Color fundus photograph:
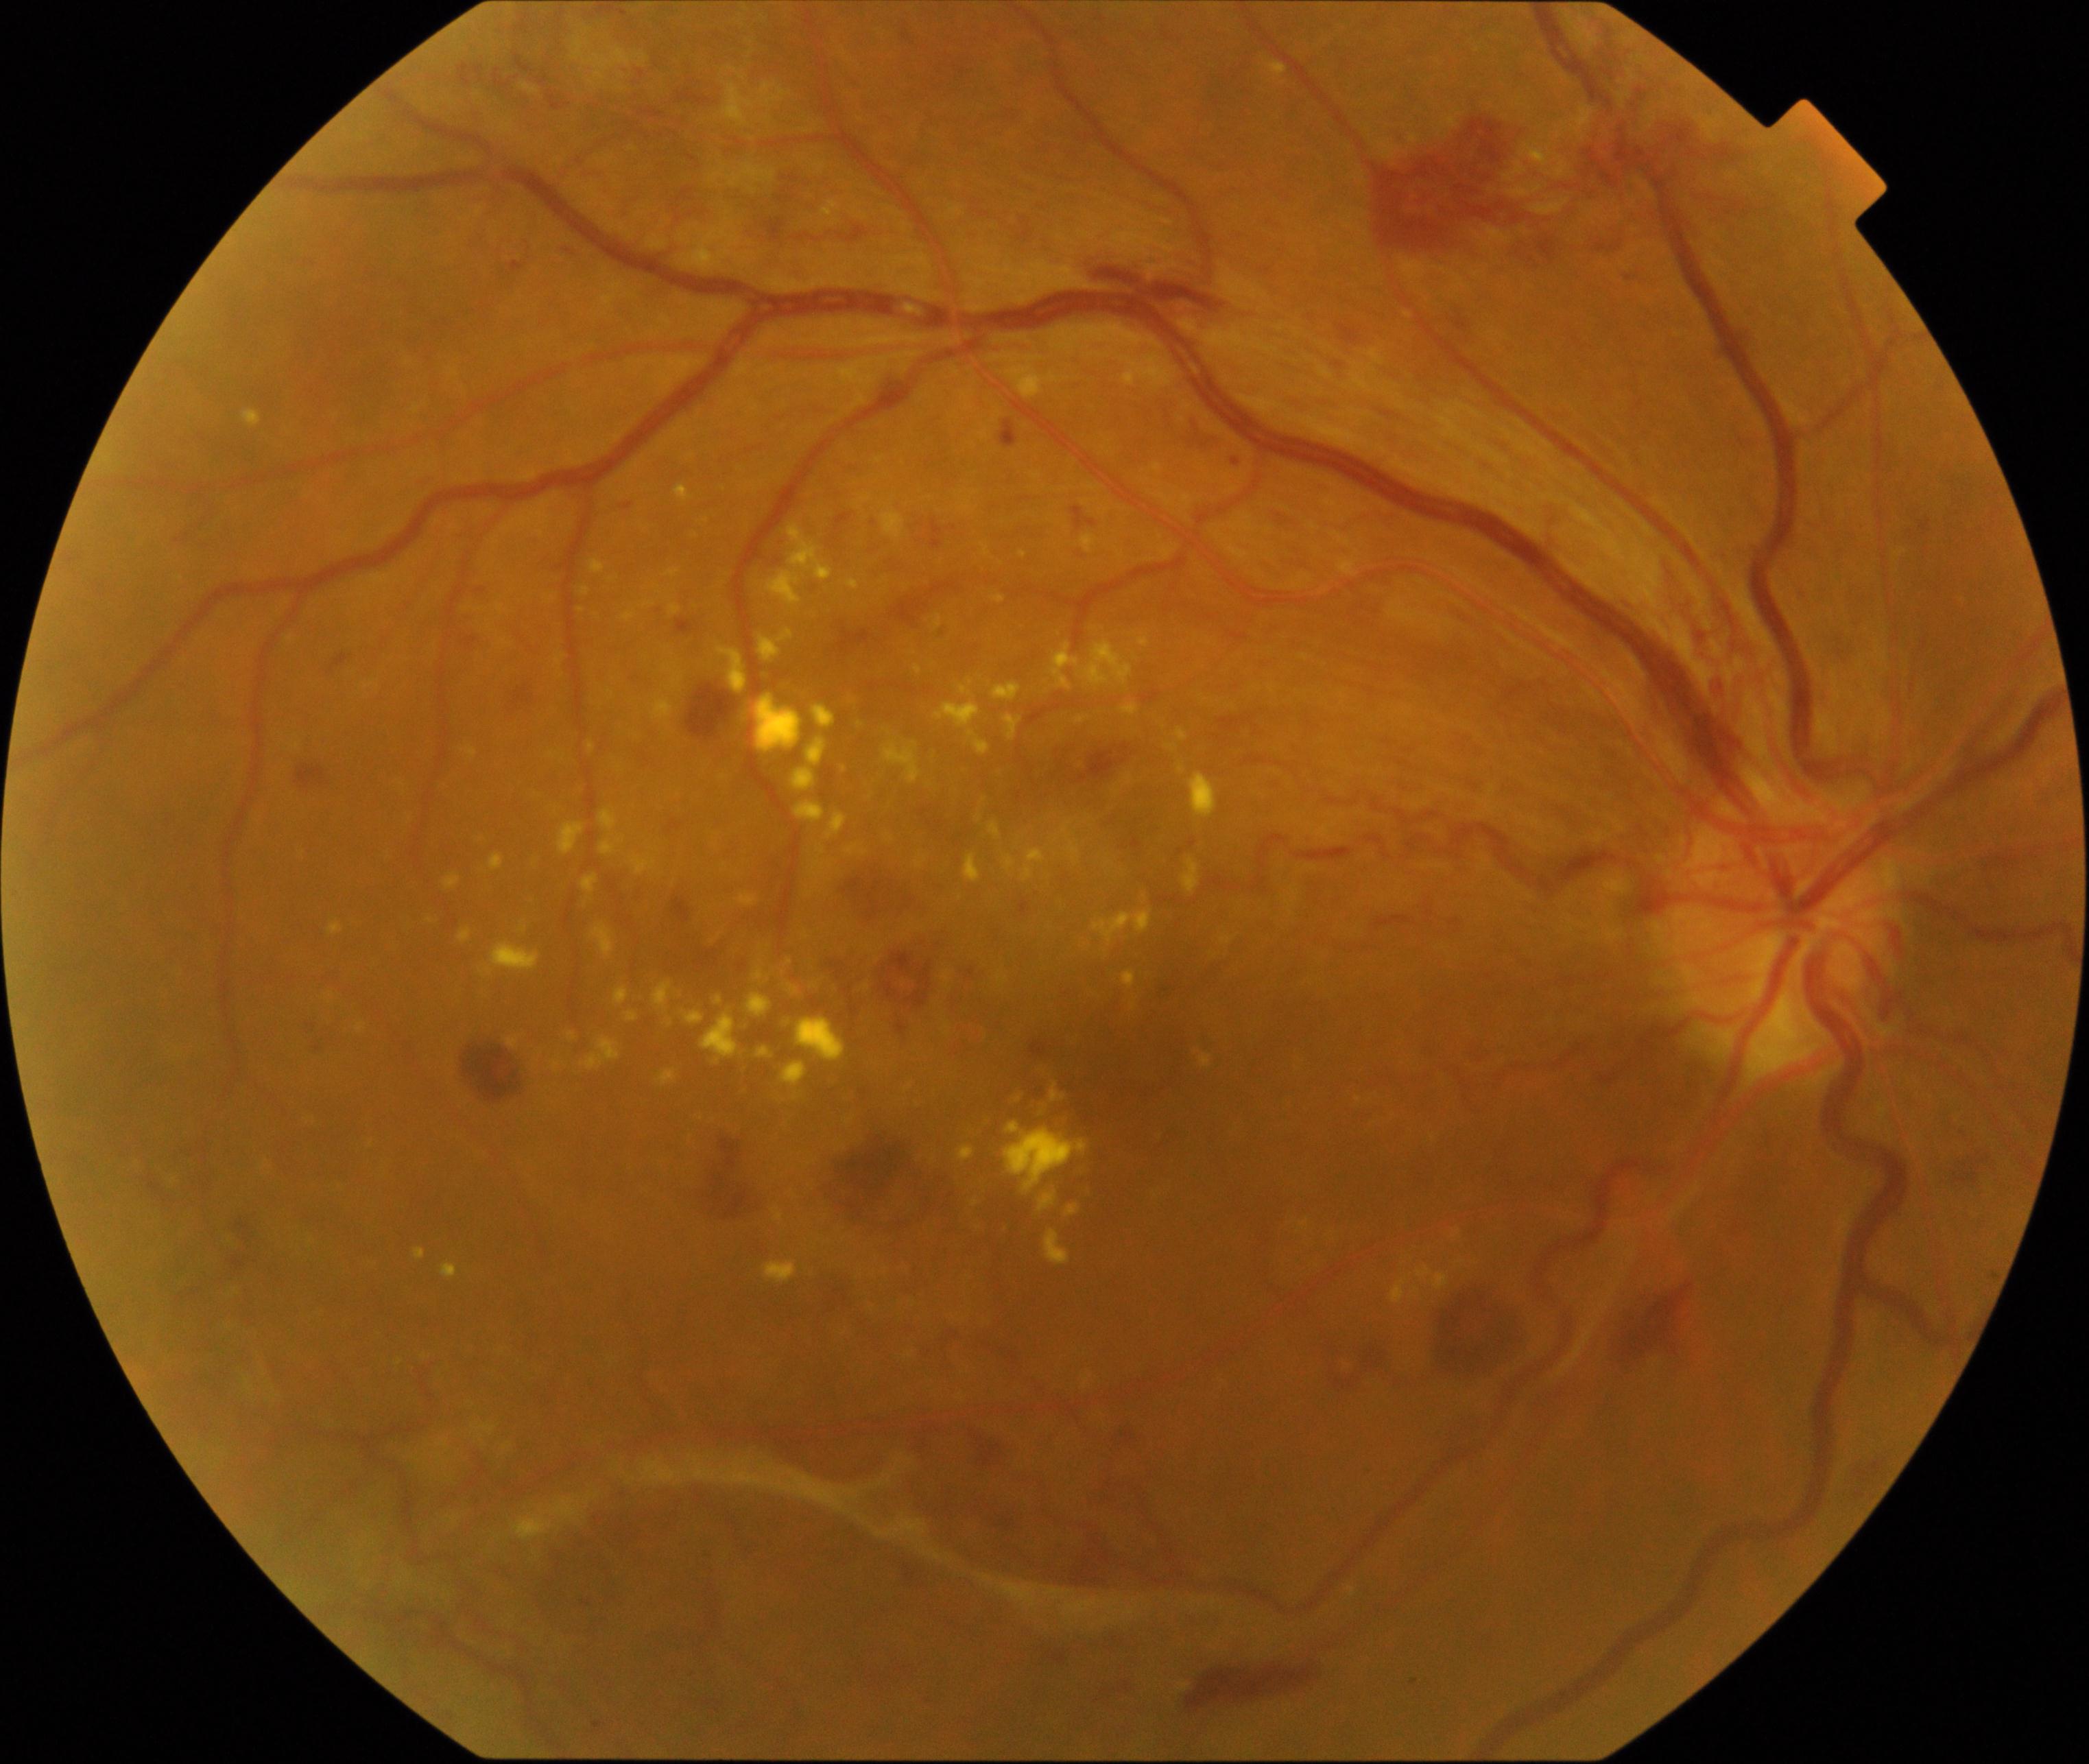 Appearance consistent with severe non-proliferative or proliferative diabetic retinopathy.